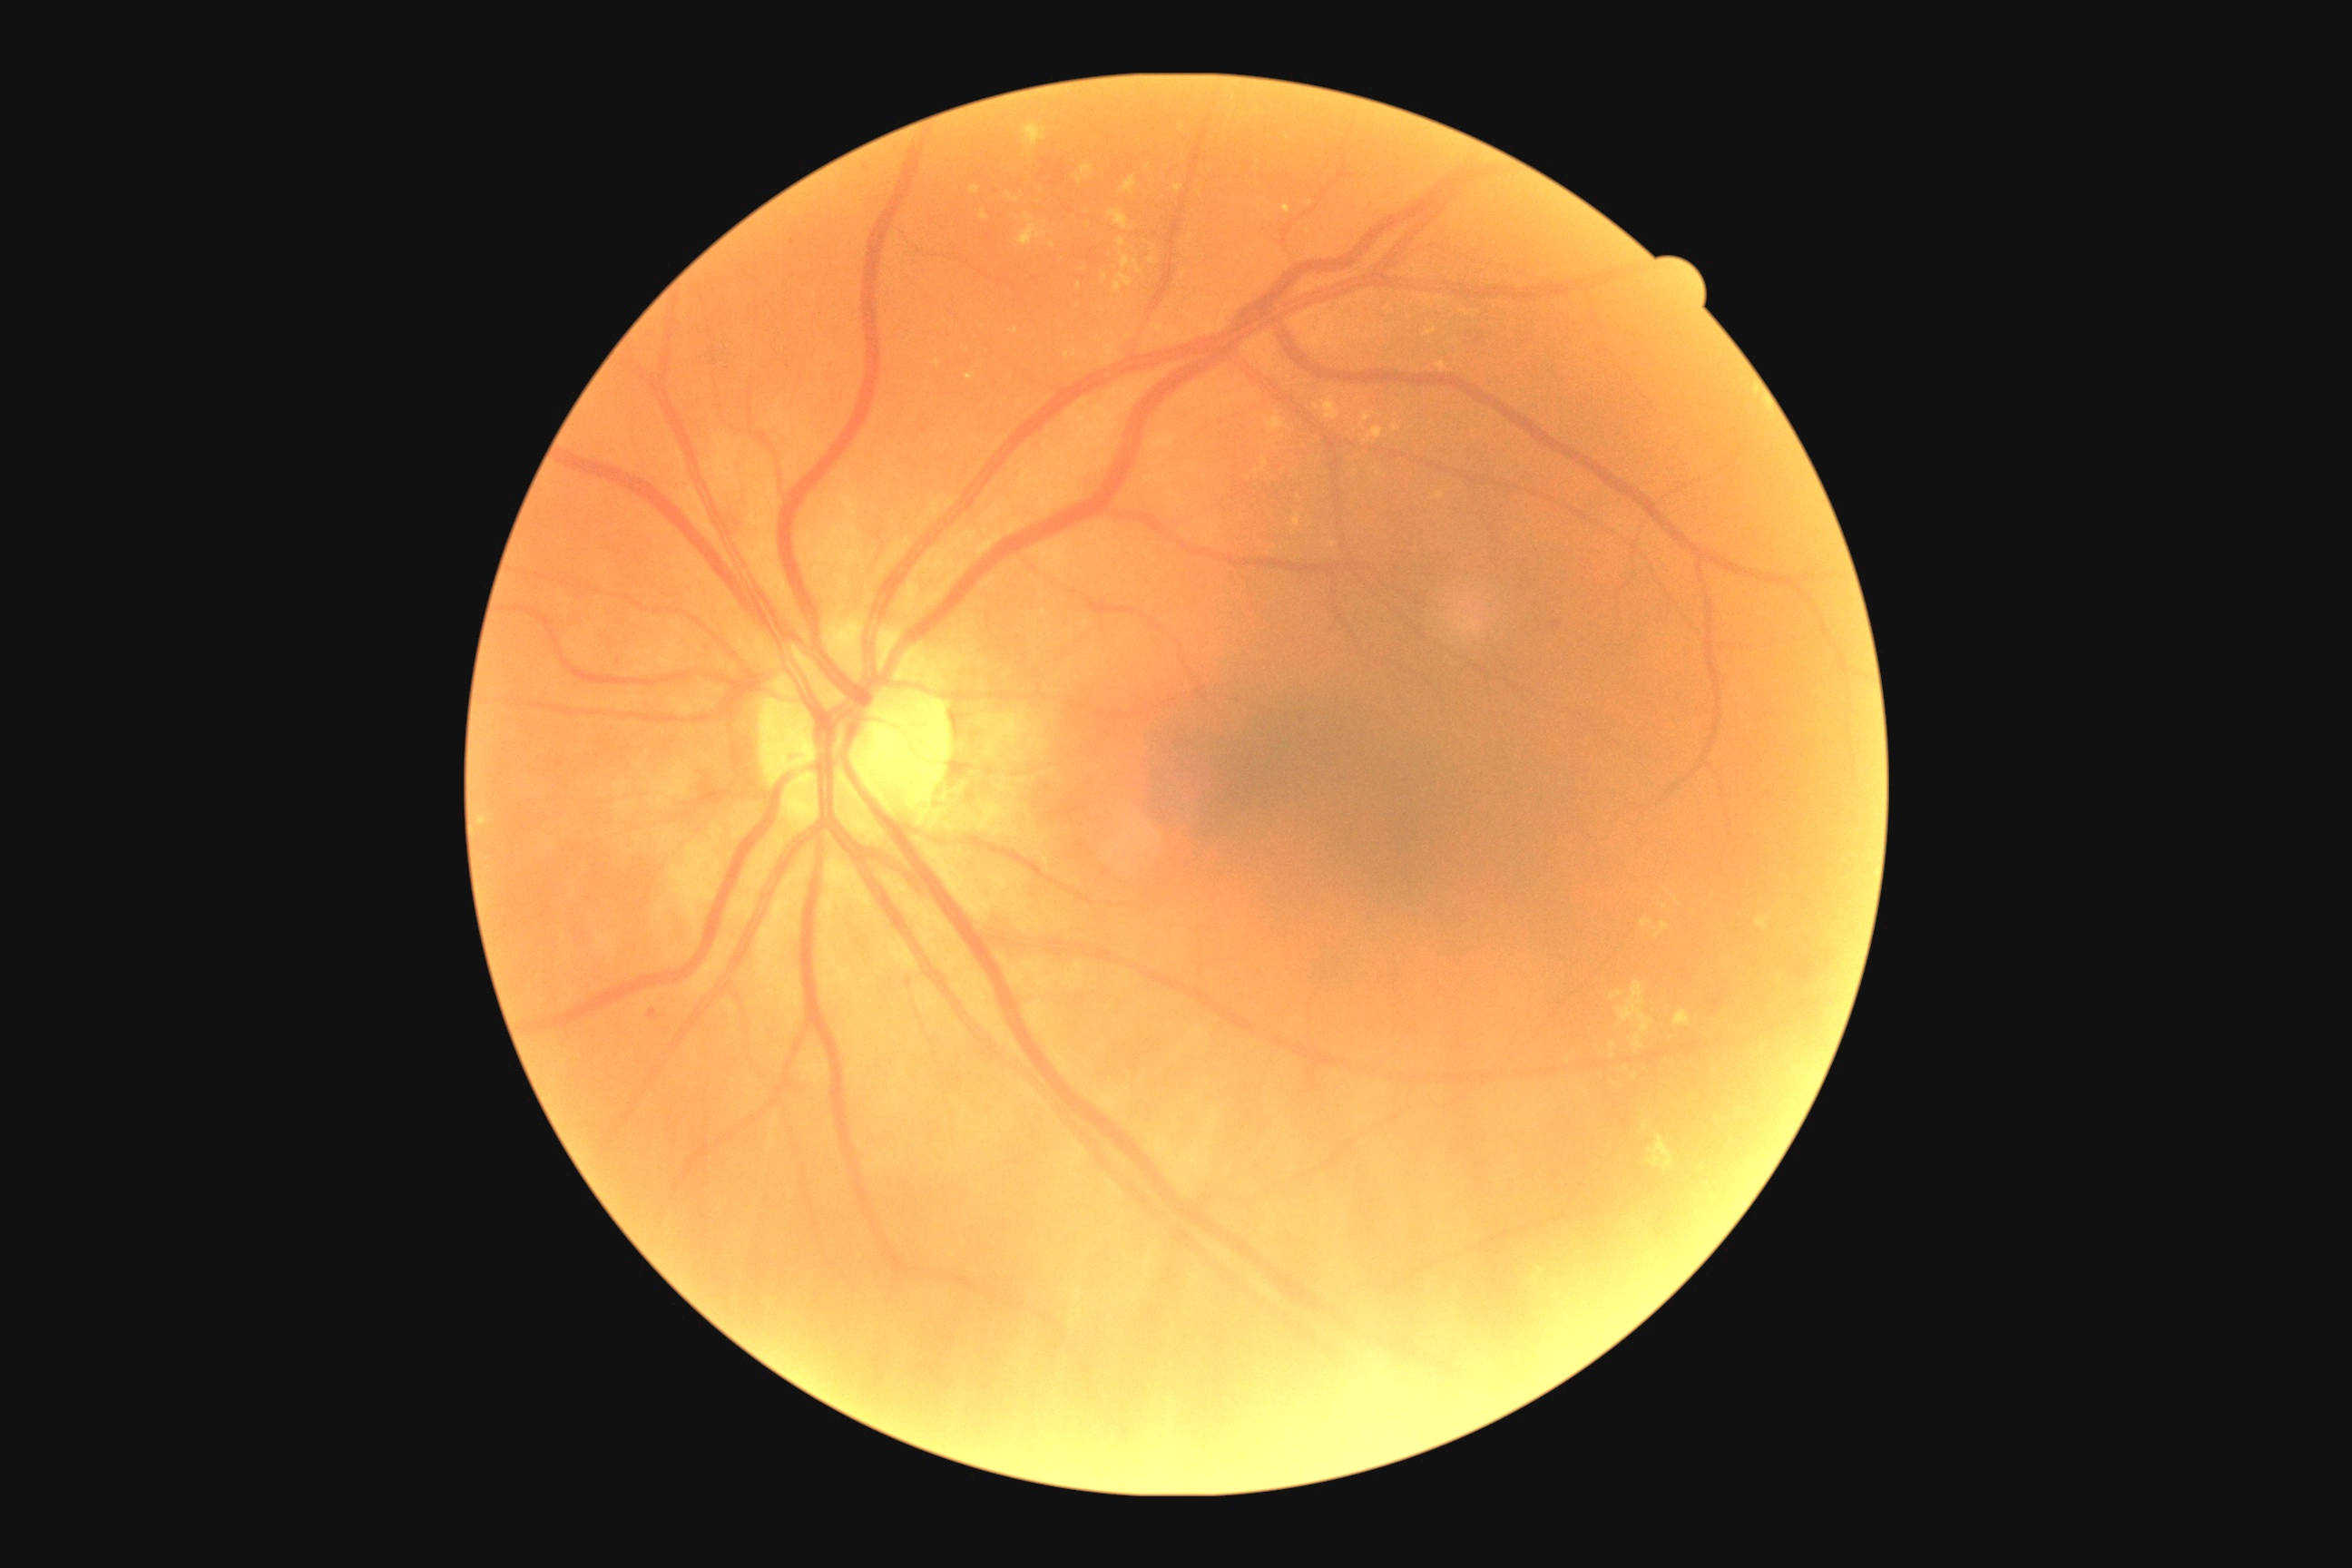 Diabetic retinopathy grade is moderate NPDR (2).